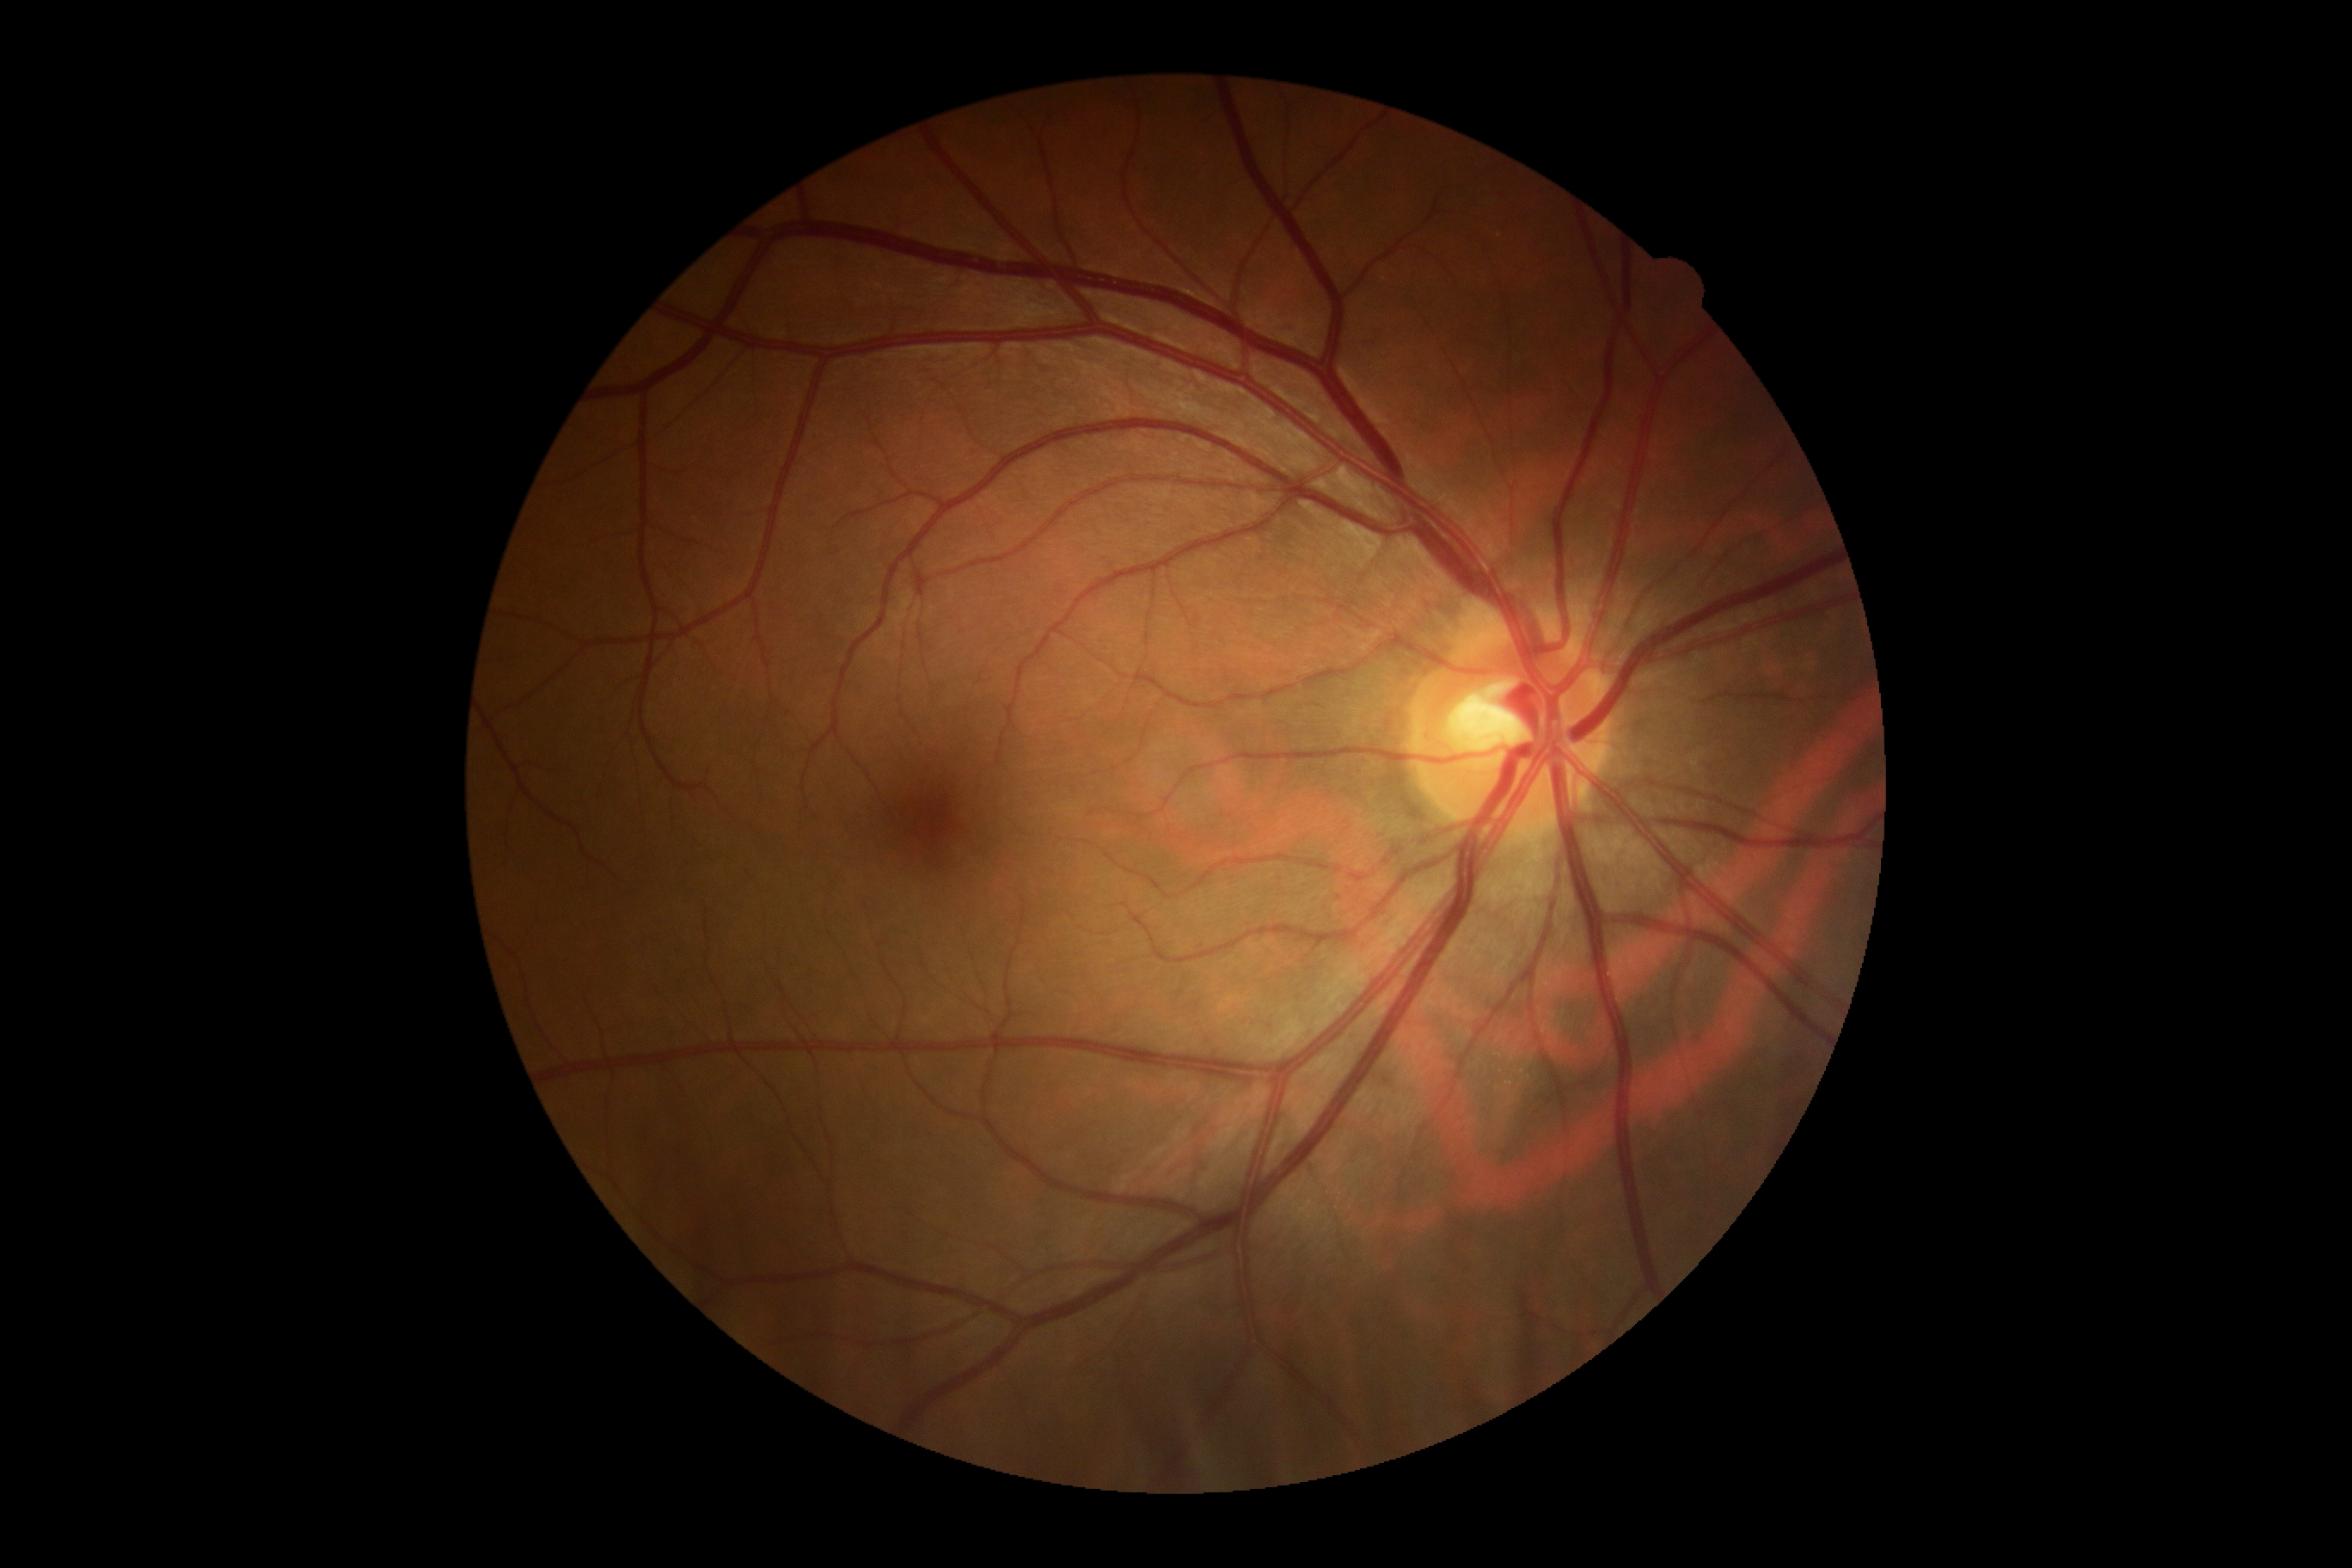 Annotations:
• DR impression: no signs of DR
• DR: 0/4